45° field of view. 2048x1536px. Fundus photo
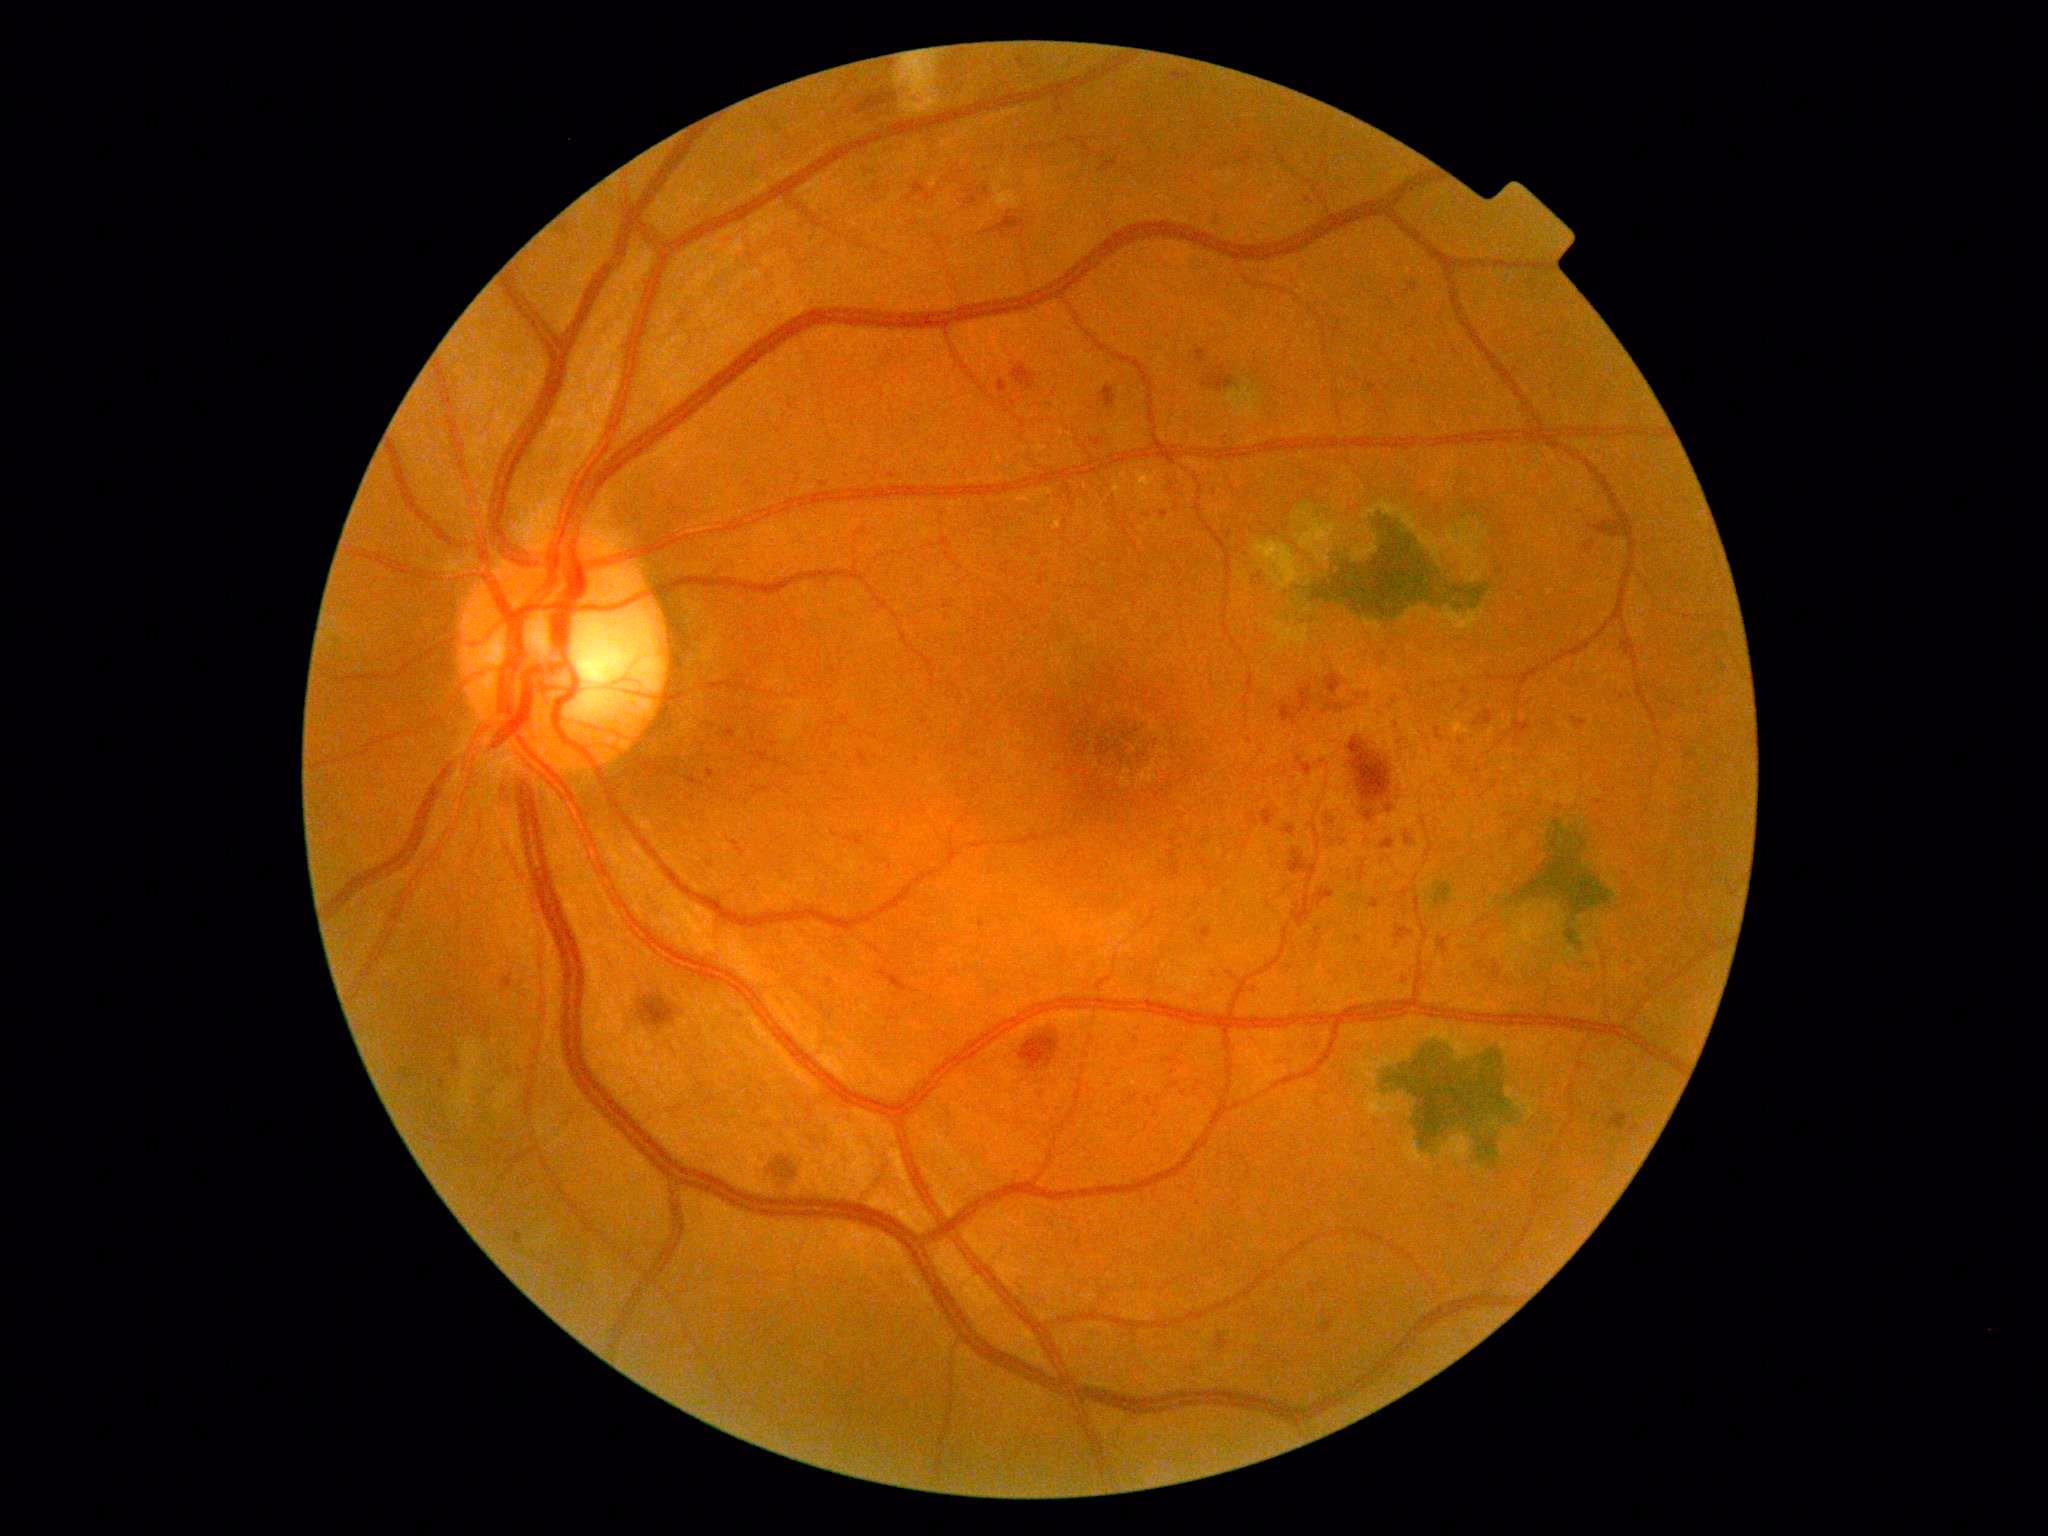

diabetic retinopathy (DR): grade 2 (moderate NPDR).